1380x1382px.
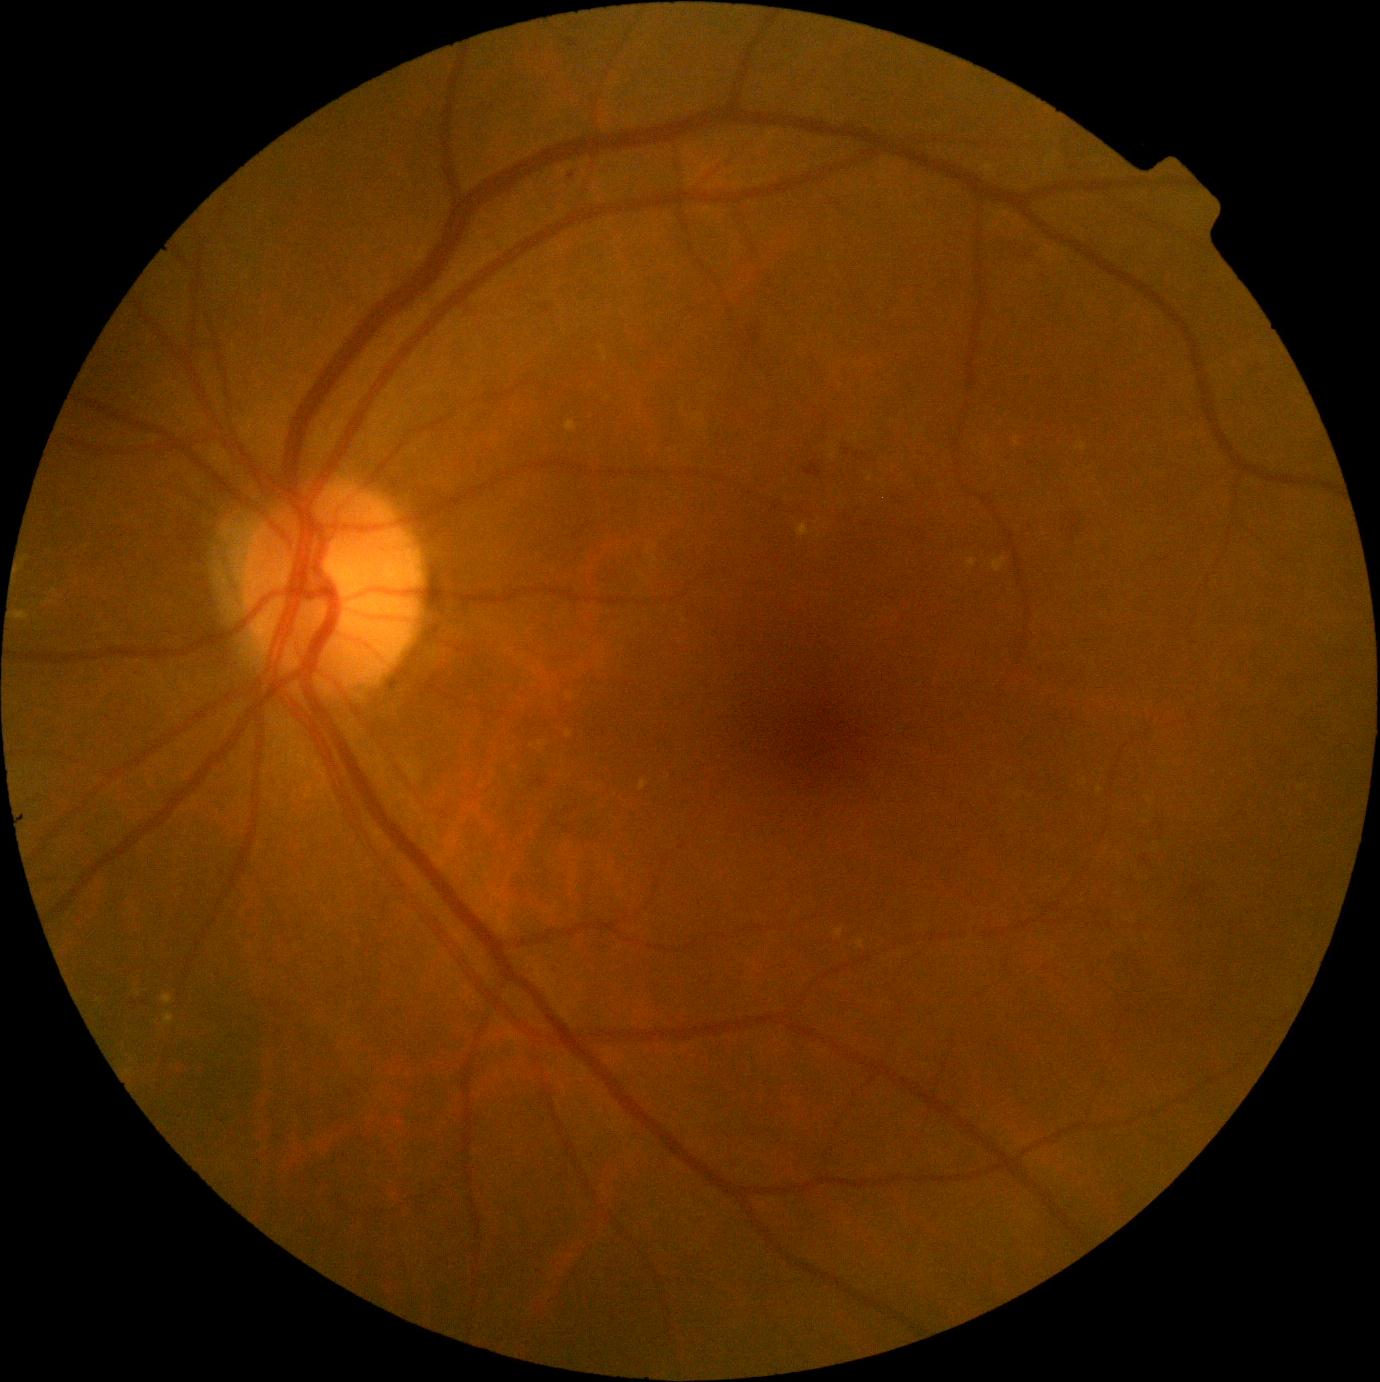

DR grade@2.